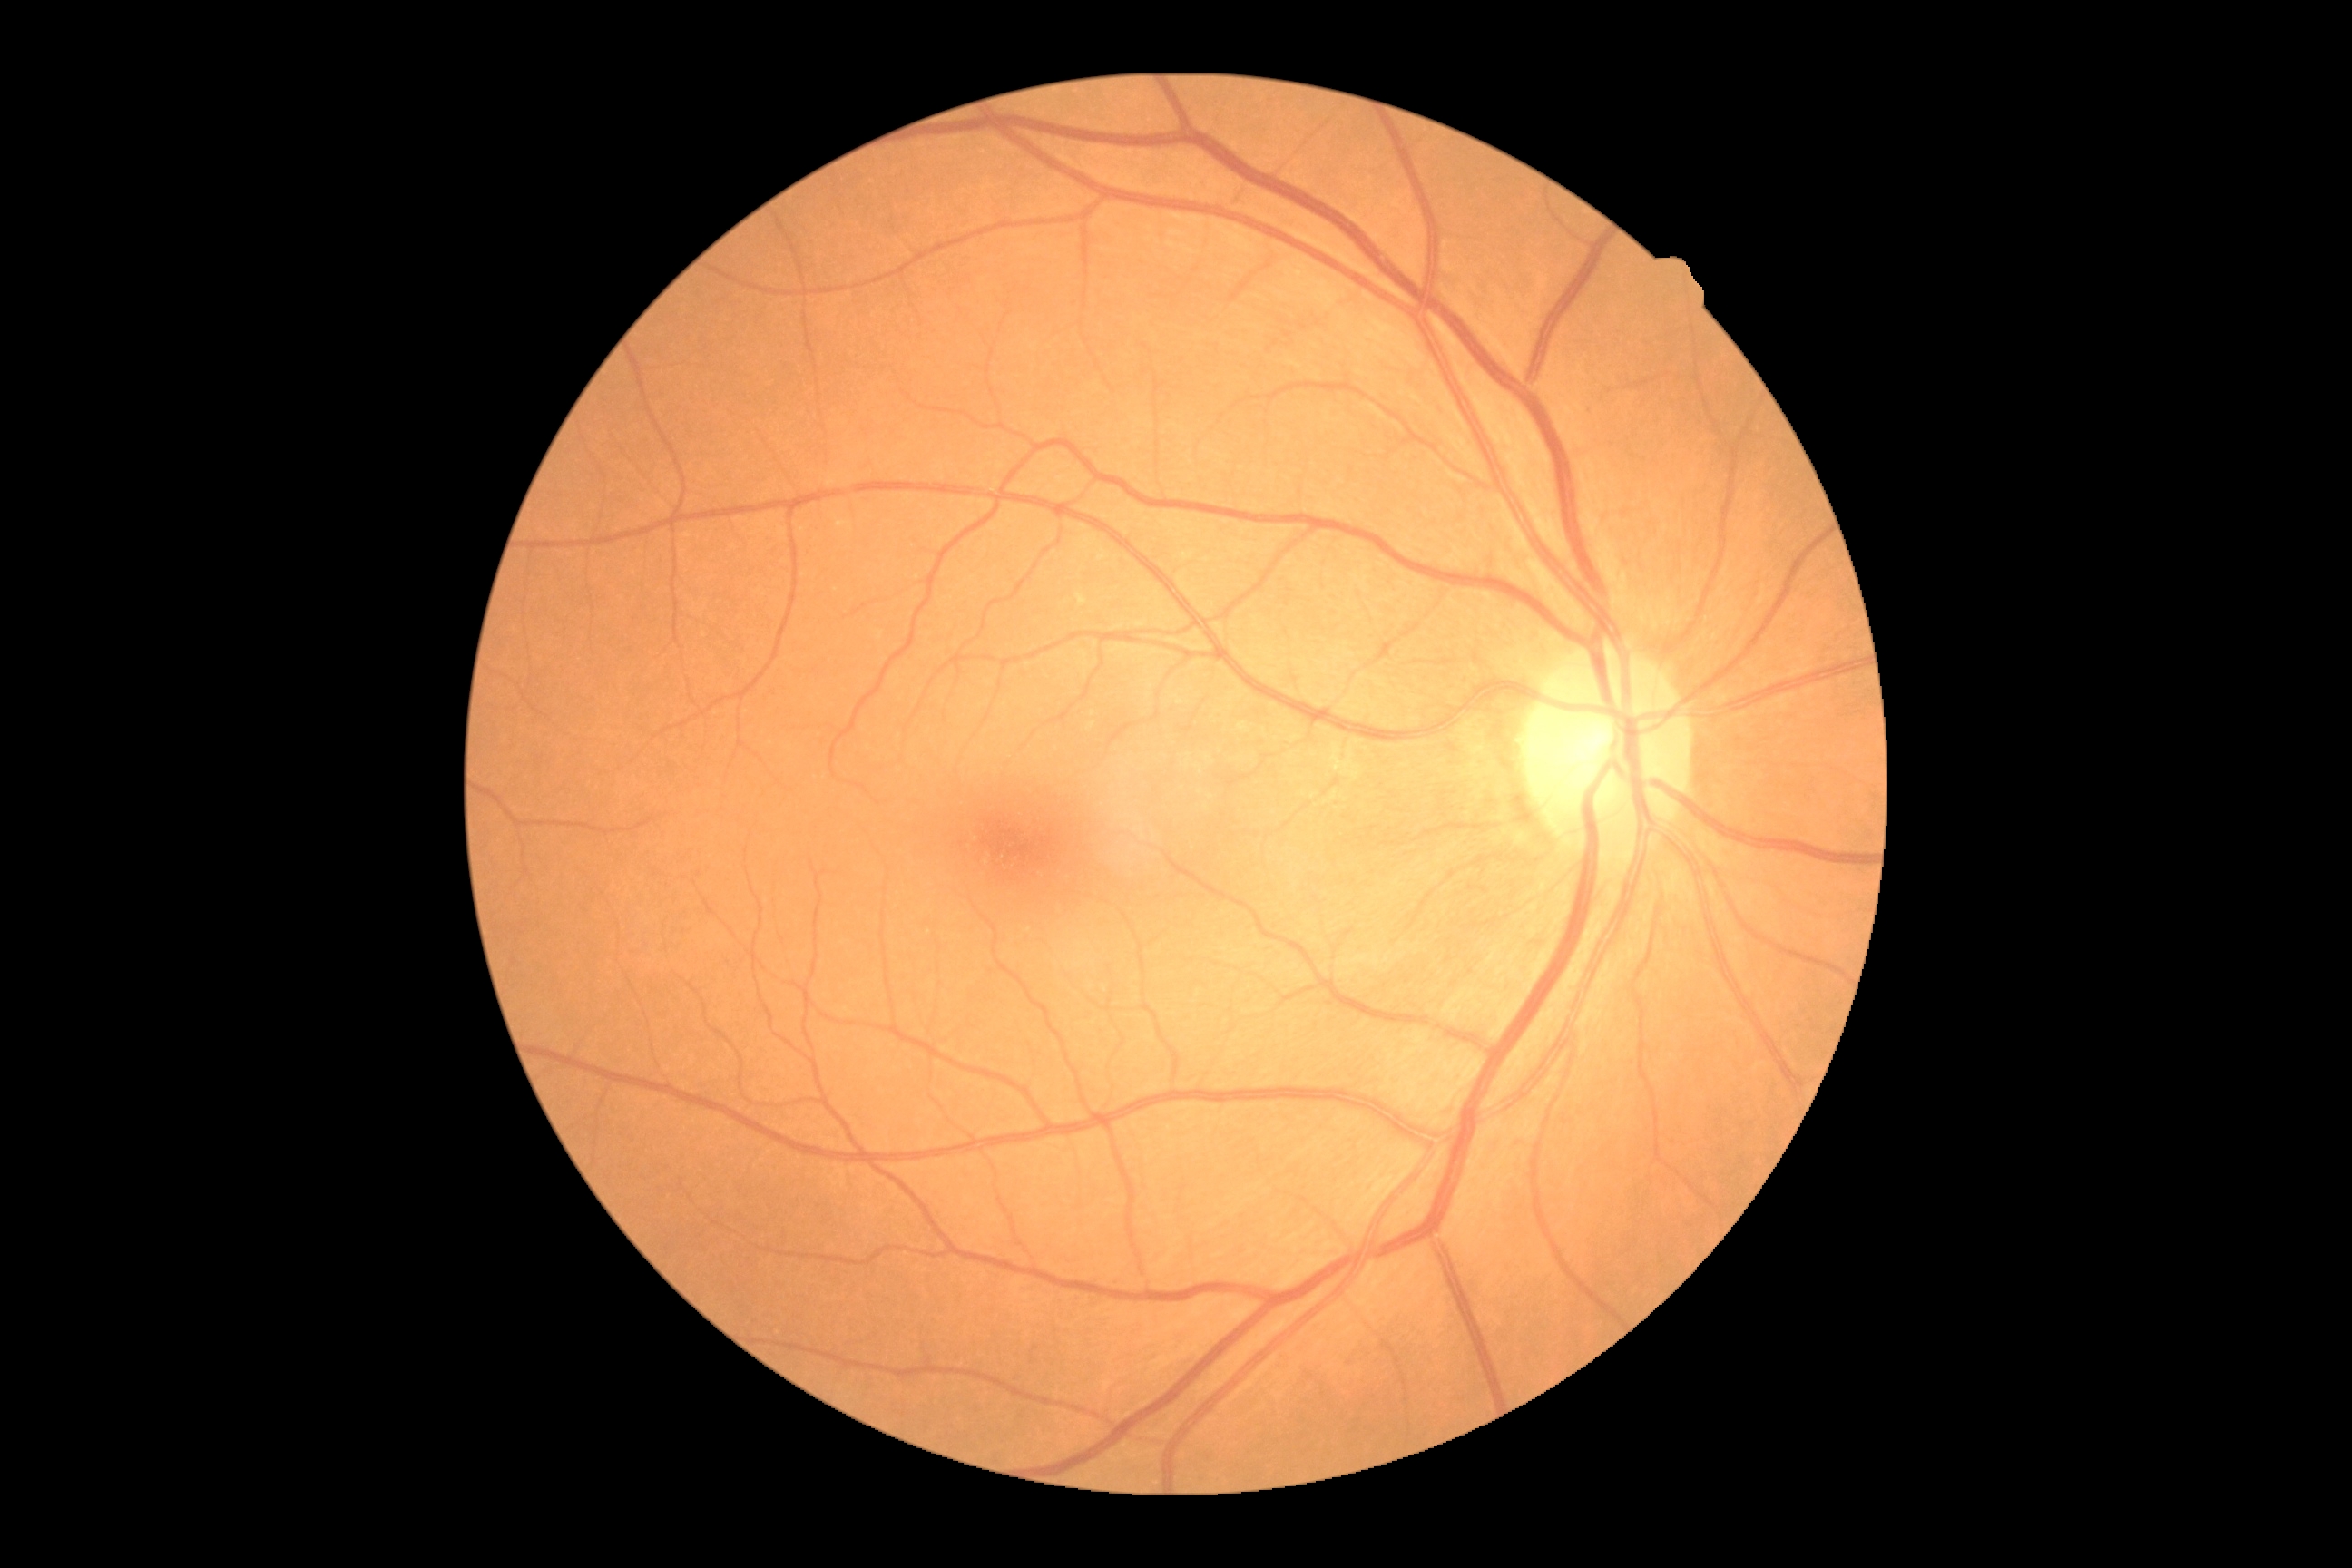
DR impression@no apparent DR, diabetic retinopathy (DR)@grade 0 (no apparent retinopathy).